2212x1659px.
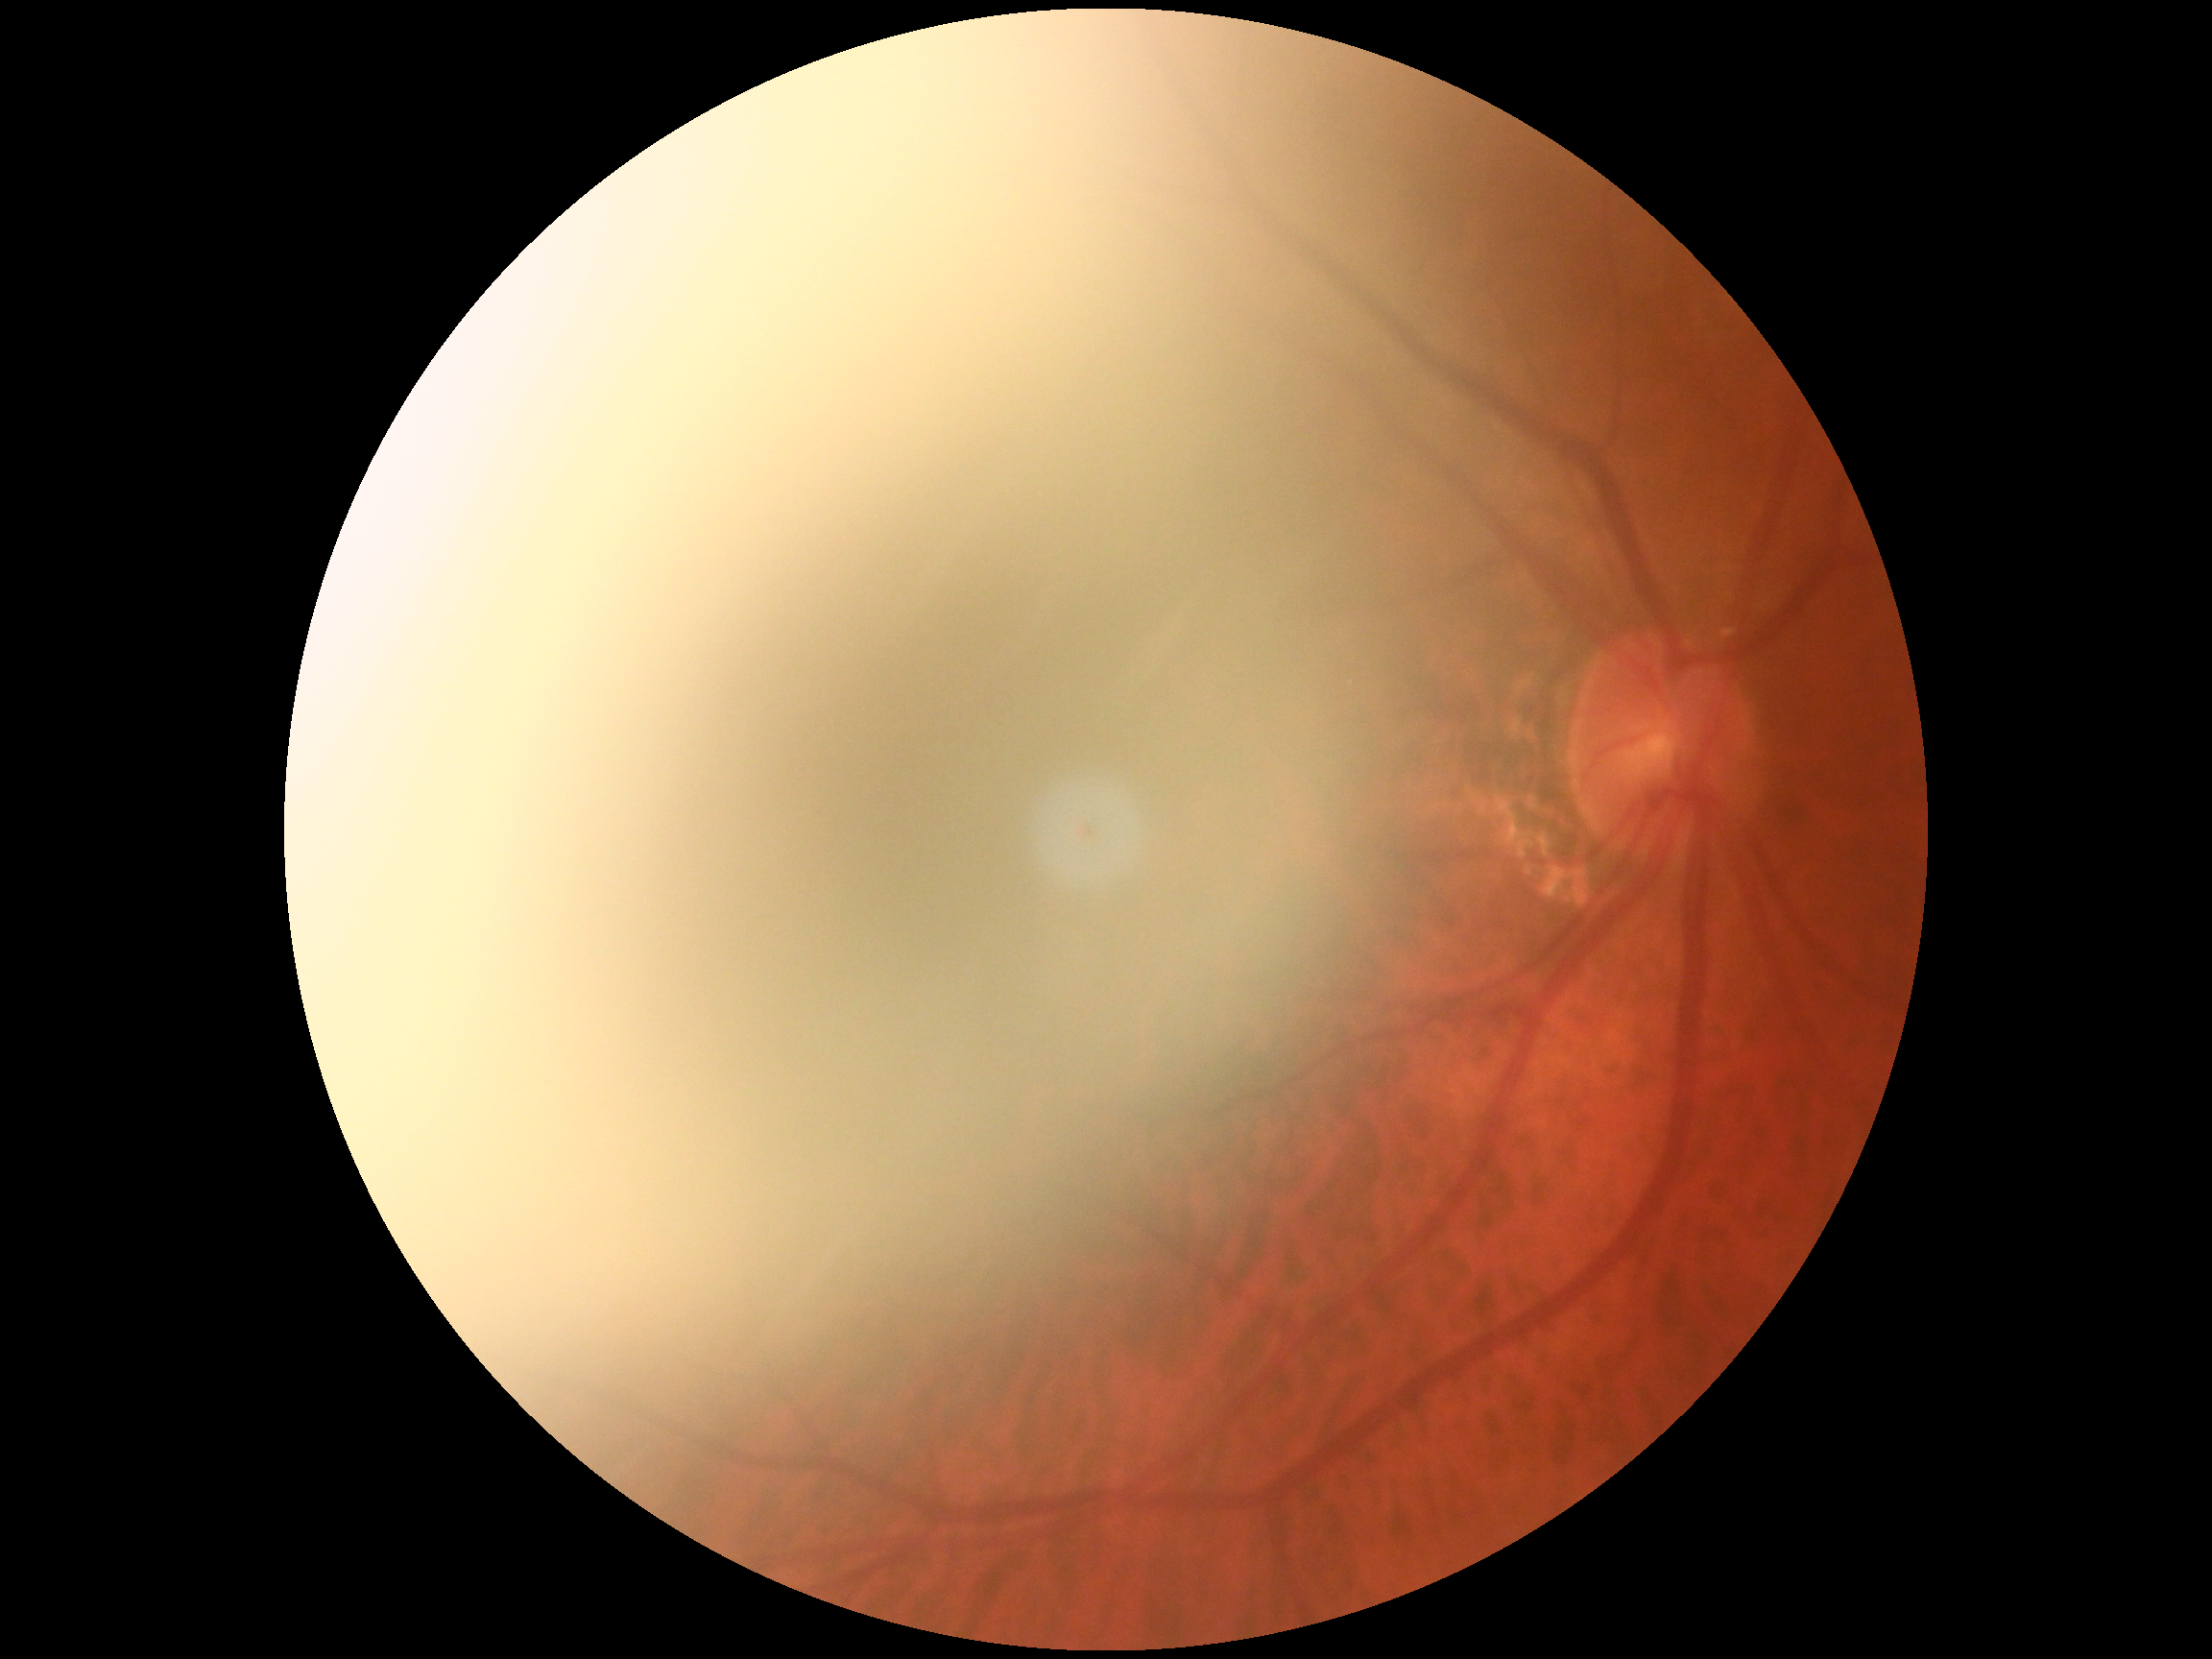

Diabetic retinopathy grade is ungradable.